Captured on a Topcon TRC-50DX fundus camera, FOV: 50 degrees: 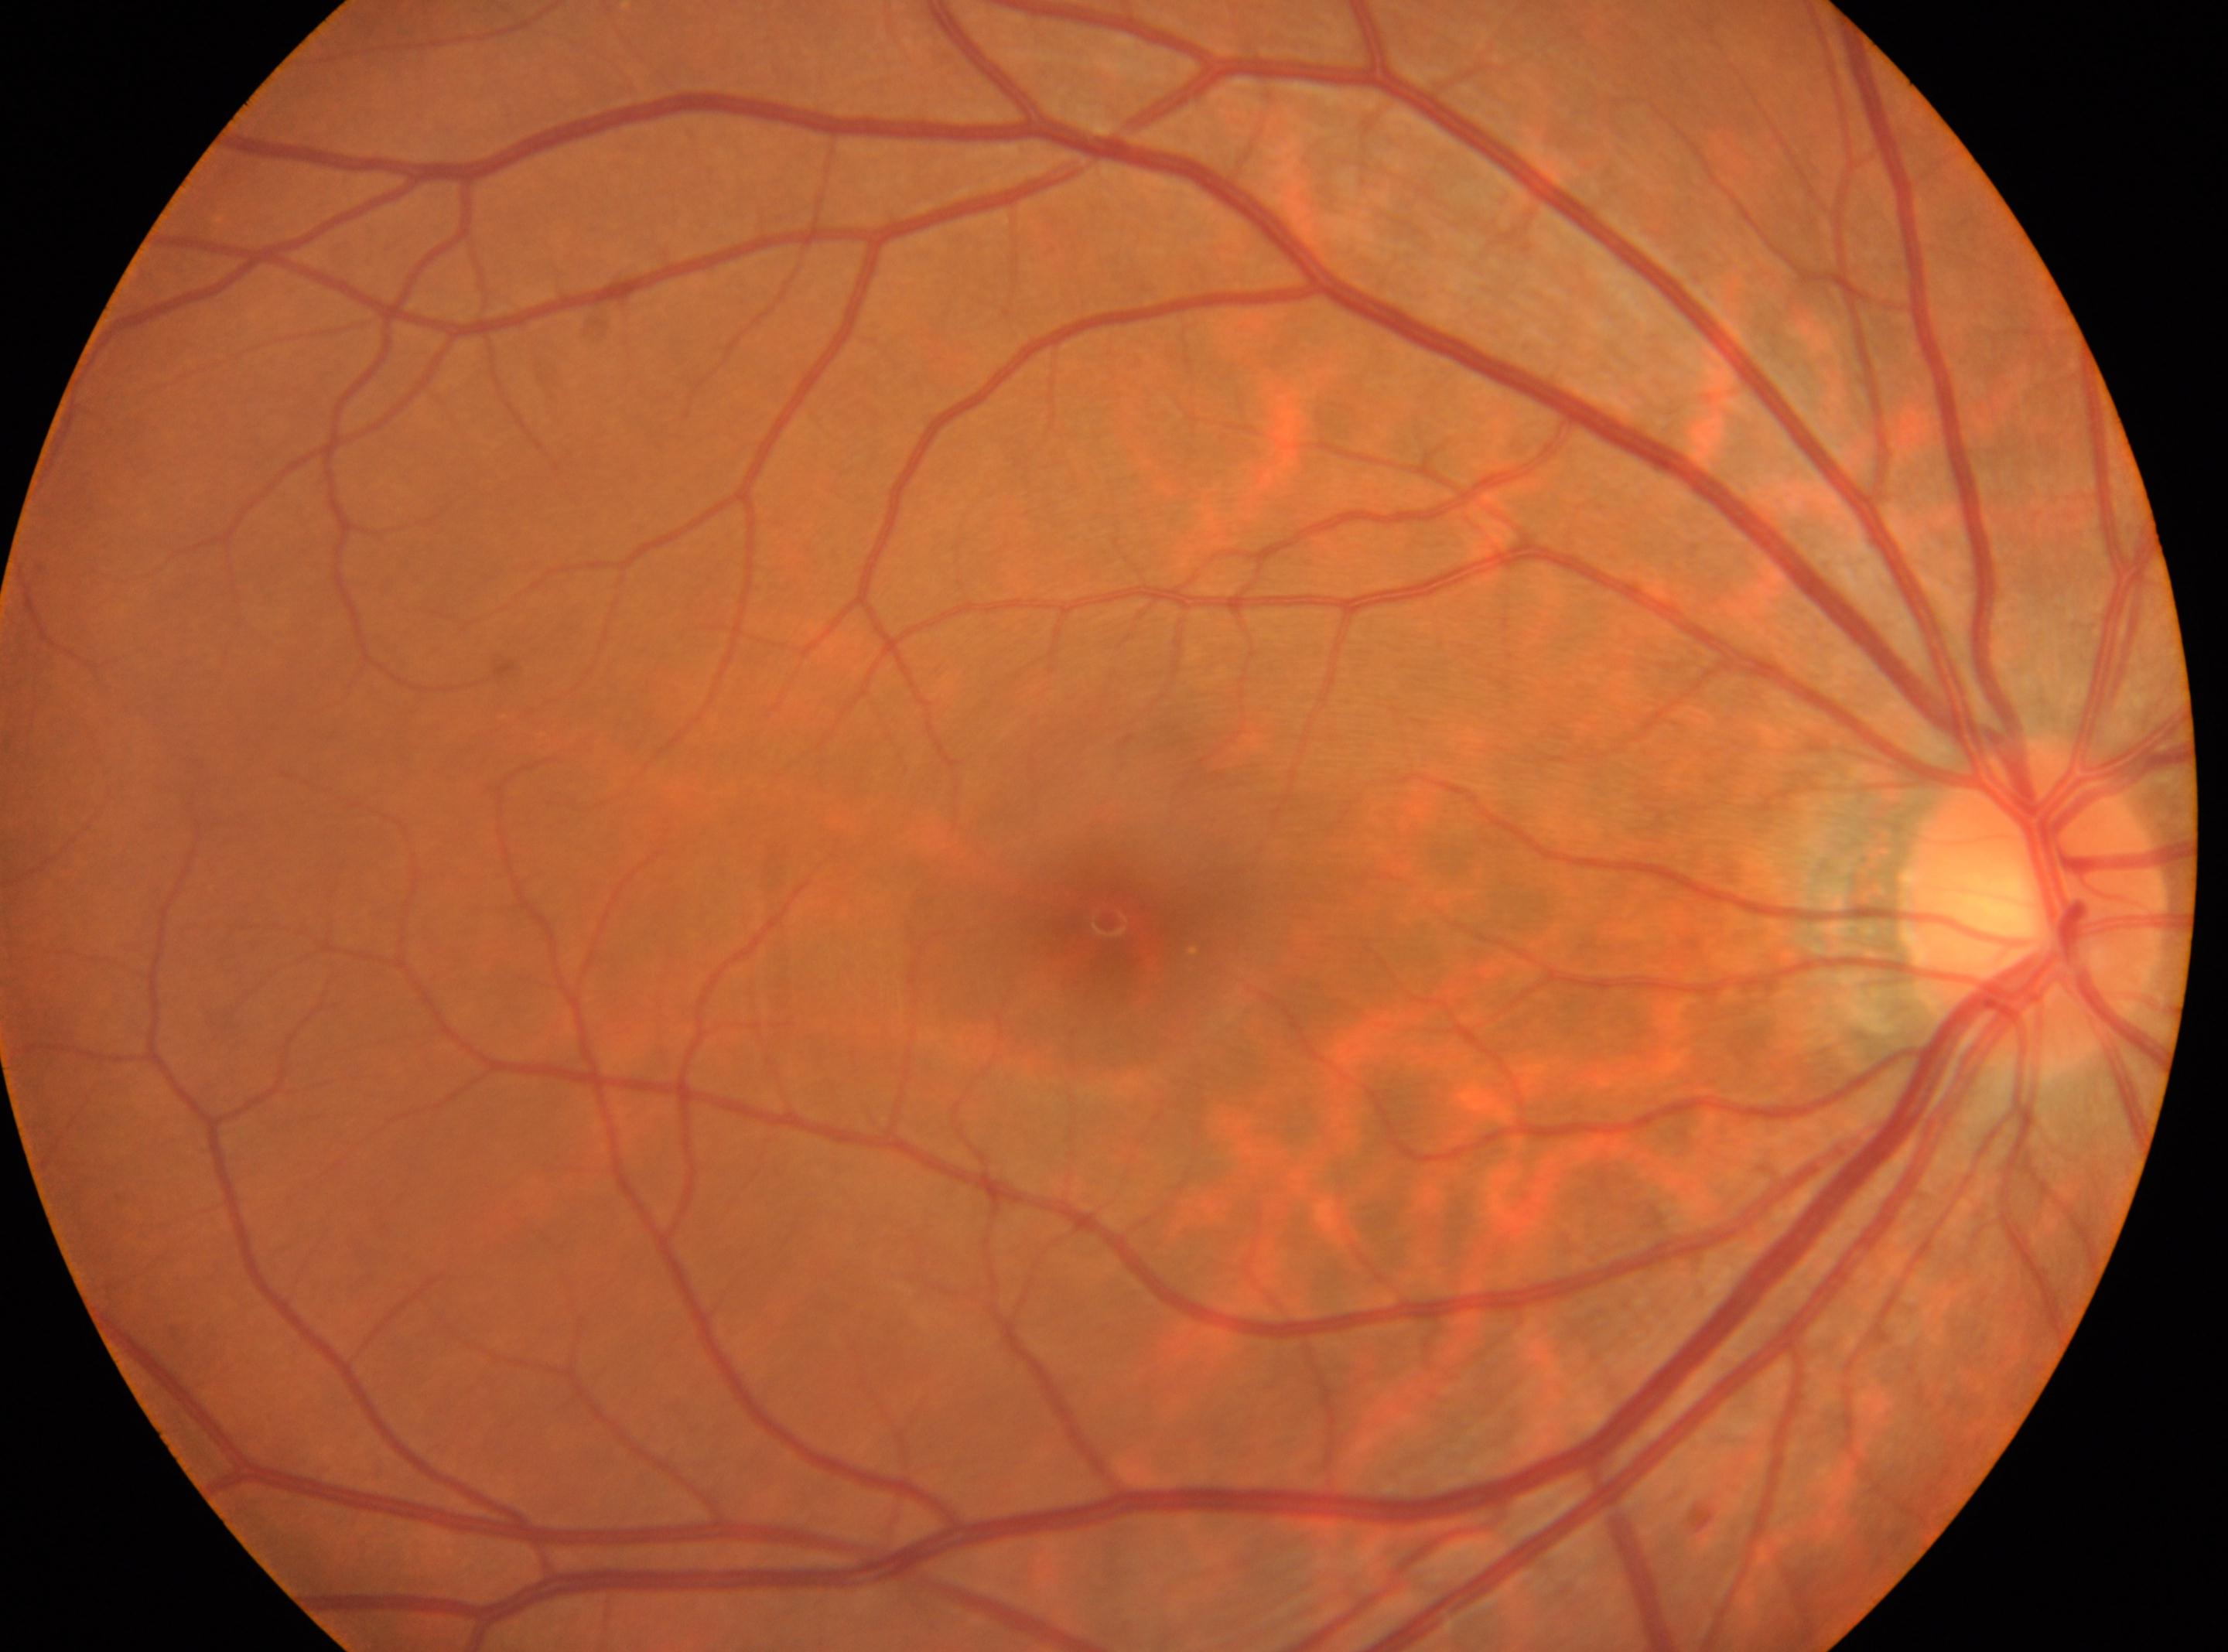
Fovea center: x=1106, y=922. DR grade: 0/4 — no visible signs of diabetic retinopathy. The optic disc is at x=2036, y=908. Eye: oculus dexter.